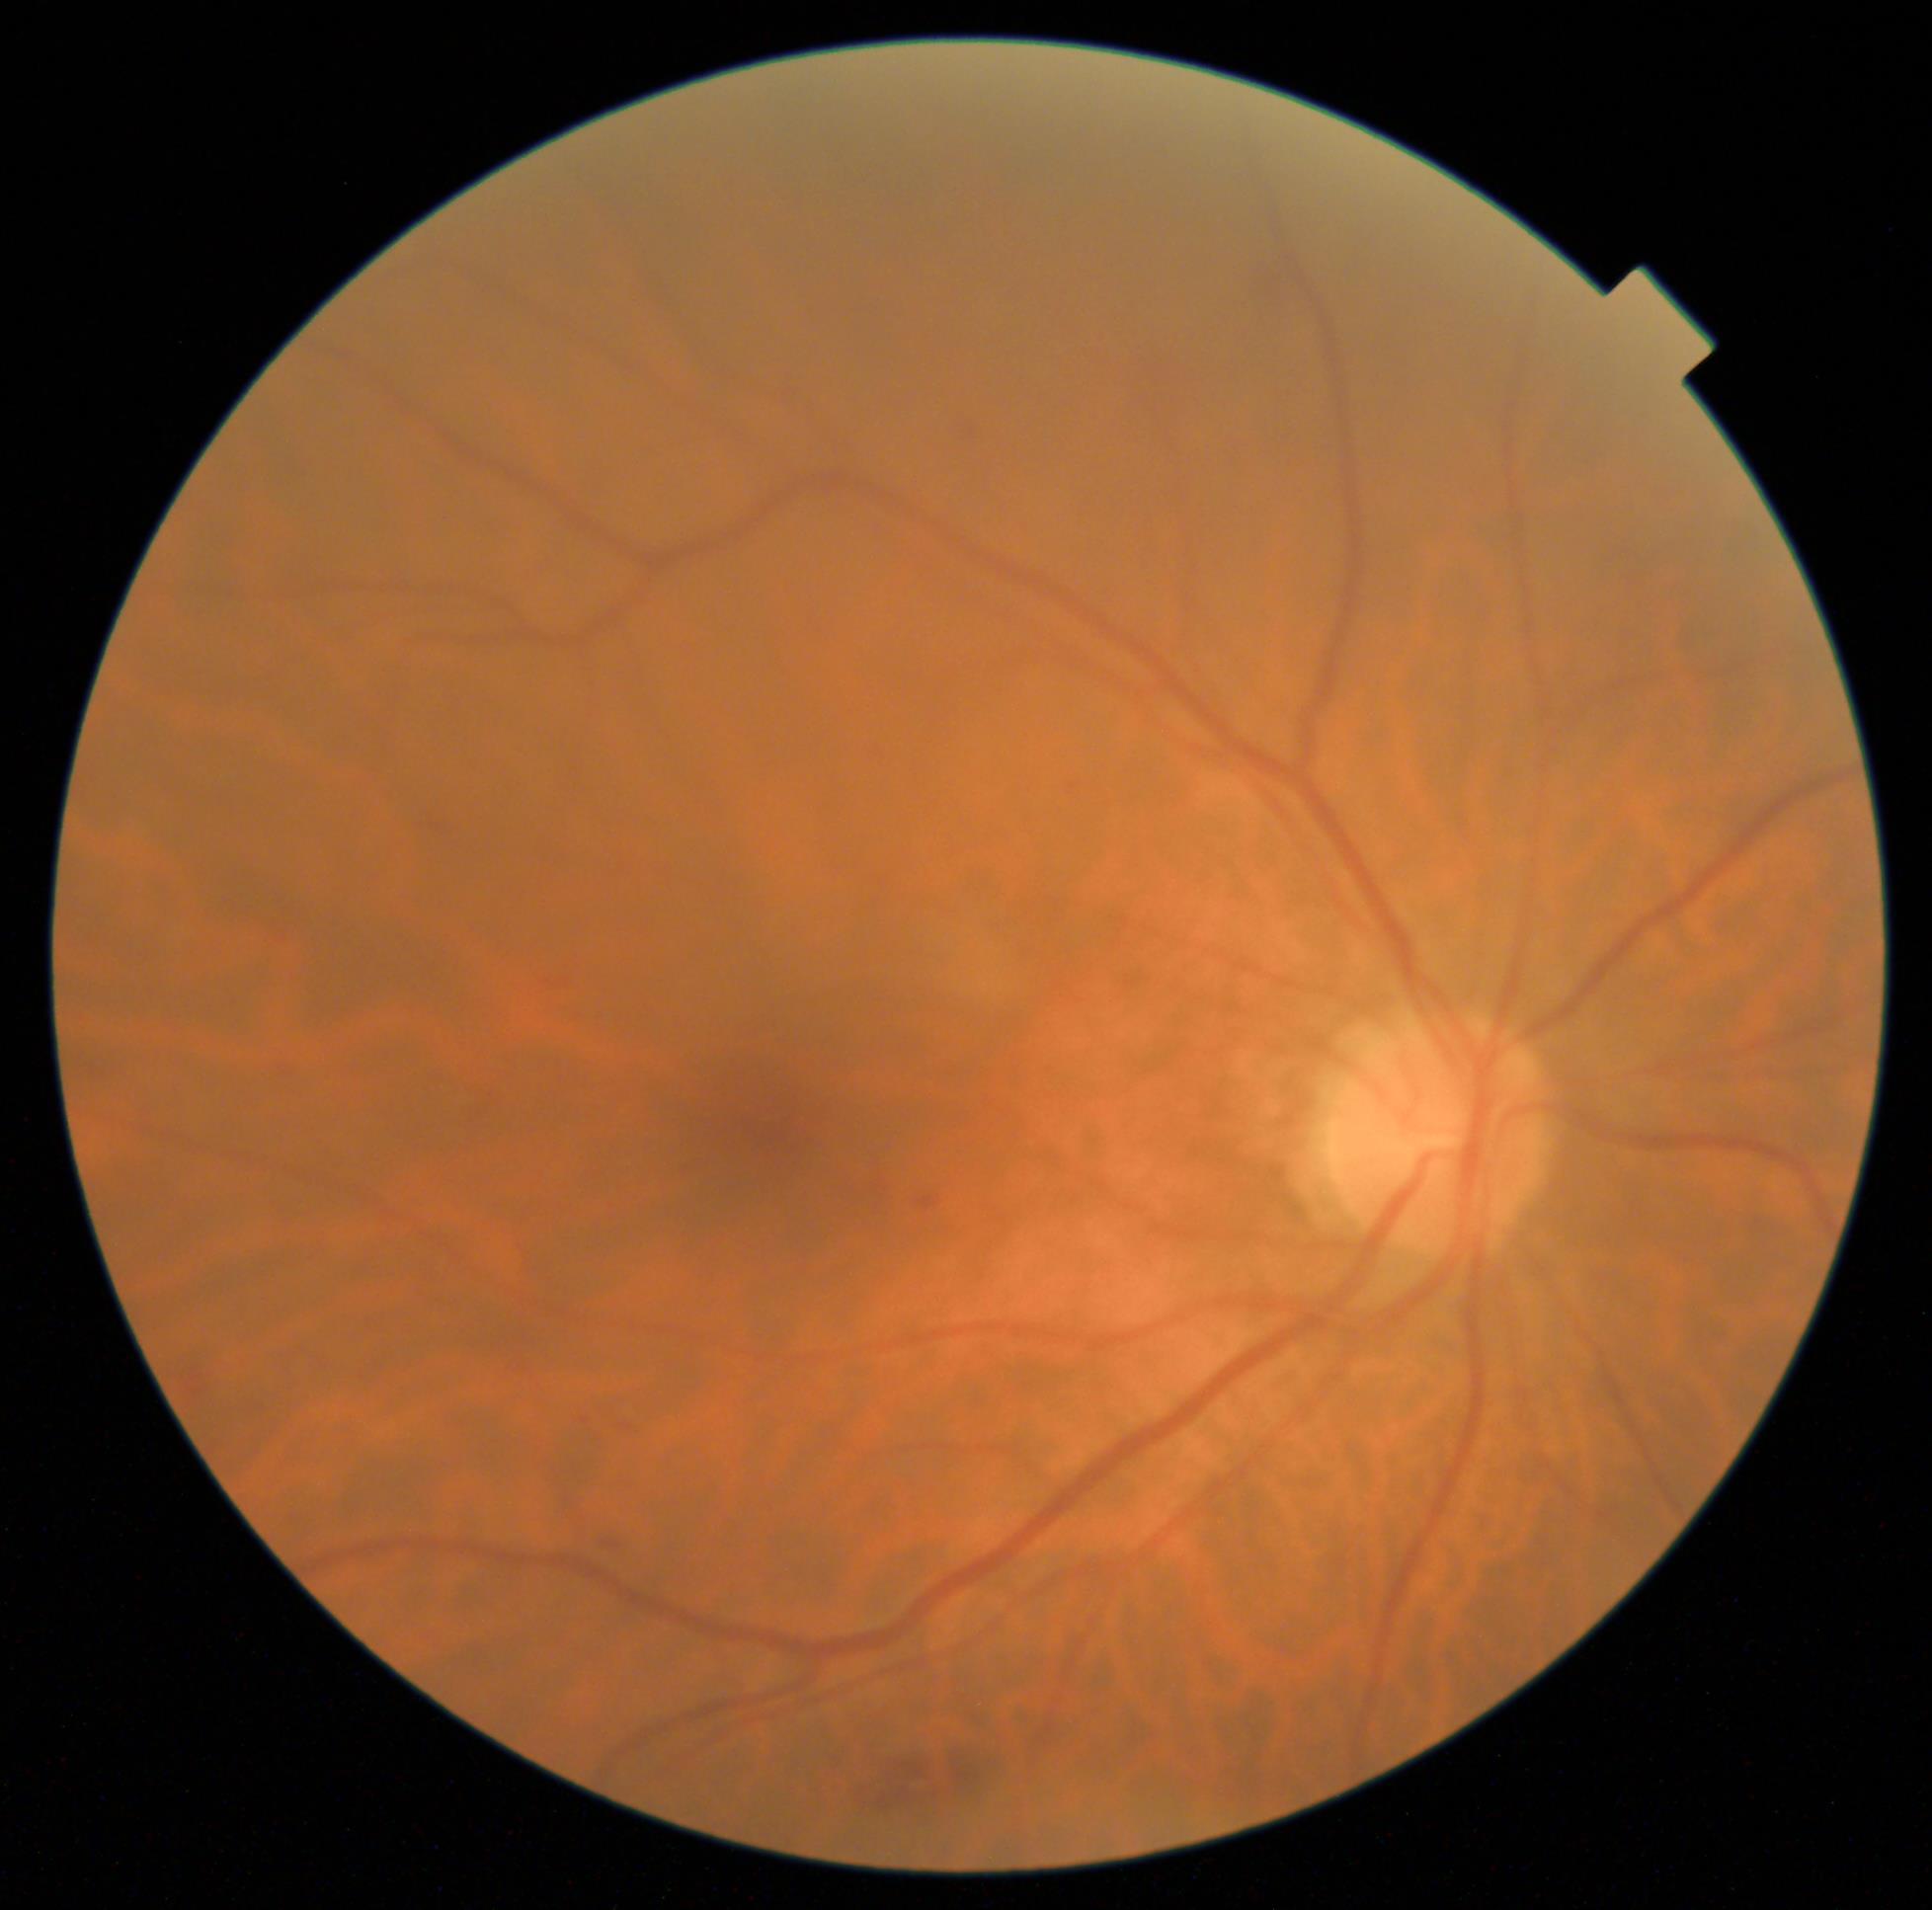
  dr_grade: moderate non-proliferative diabetic retinopathy (grade 2)